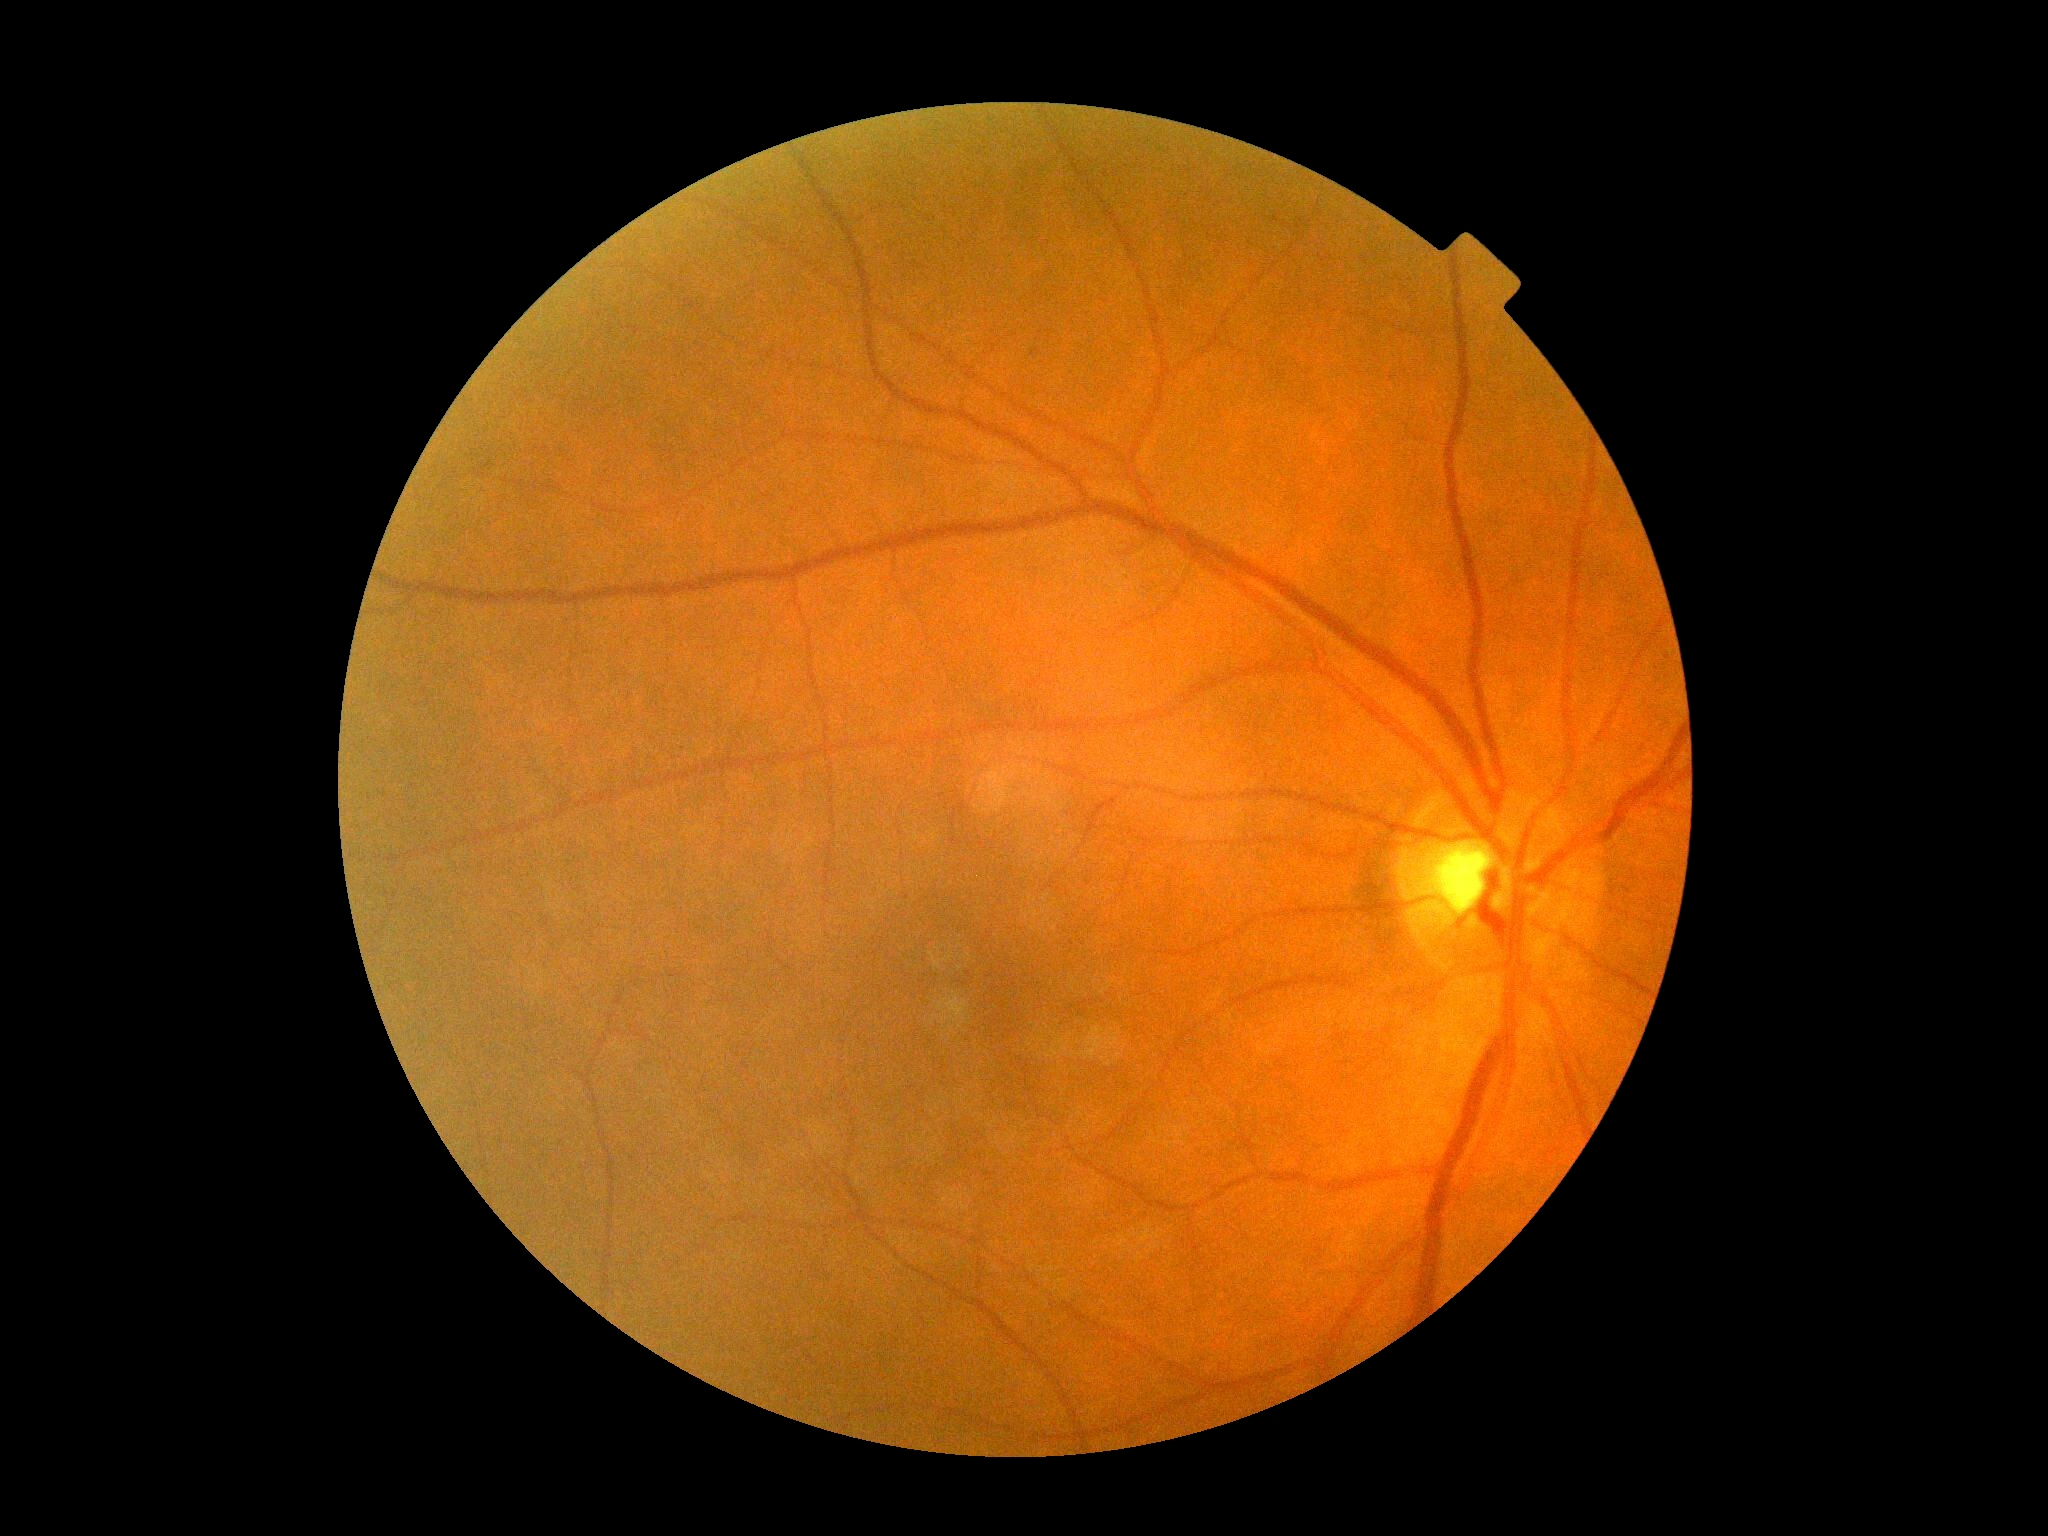 DR impression = negative for DR, diabetic retinopathy severity = grade 0.